Retinal fundus photograph. 1920 by 1088 pixels. 45-degree field of view.
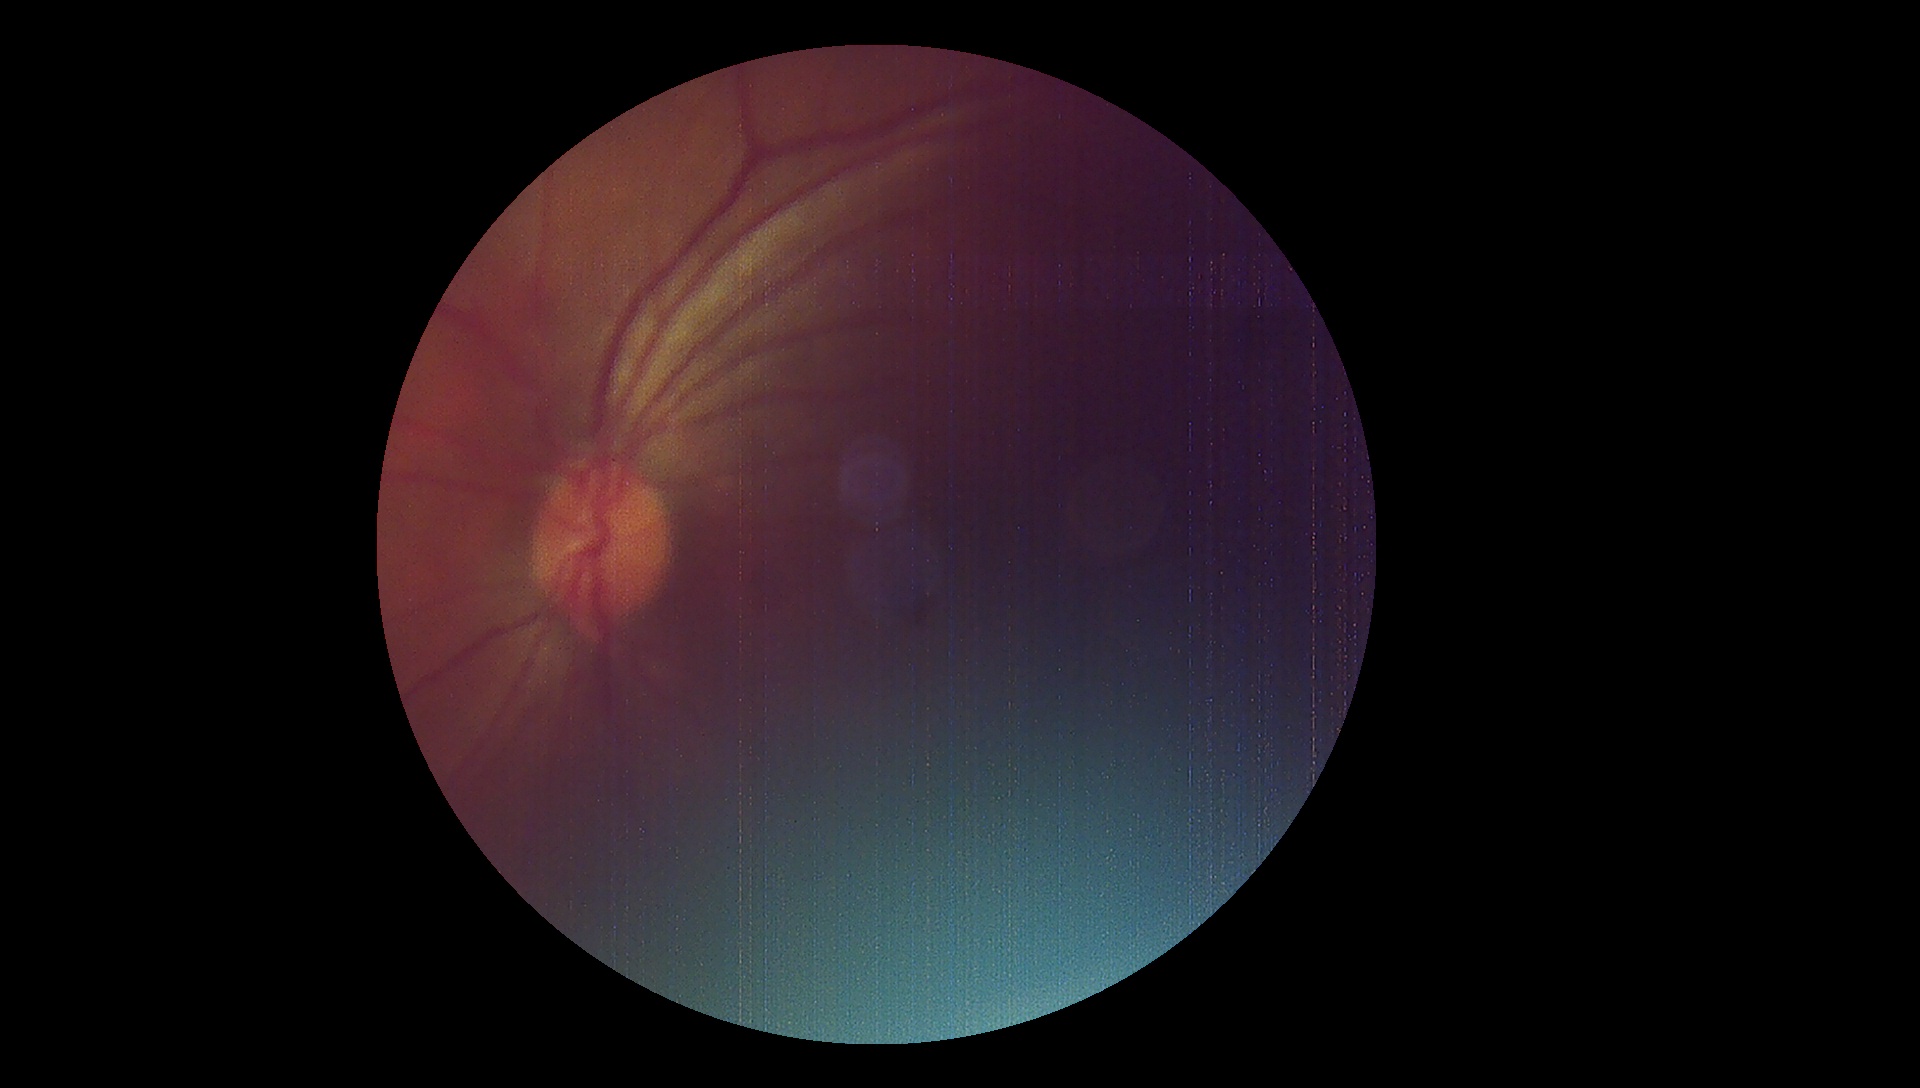 Quality too poor to assess for DR. Diabetic retinopathy (DR): ungradable.